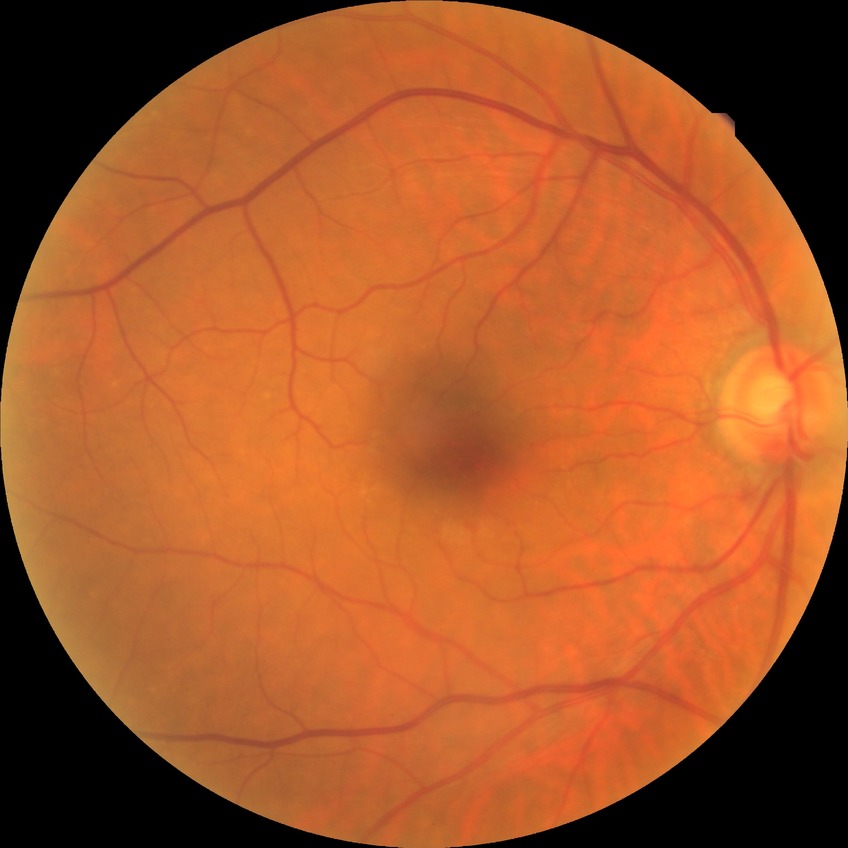 Davis grading is no diabetic retinopathy.